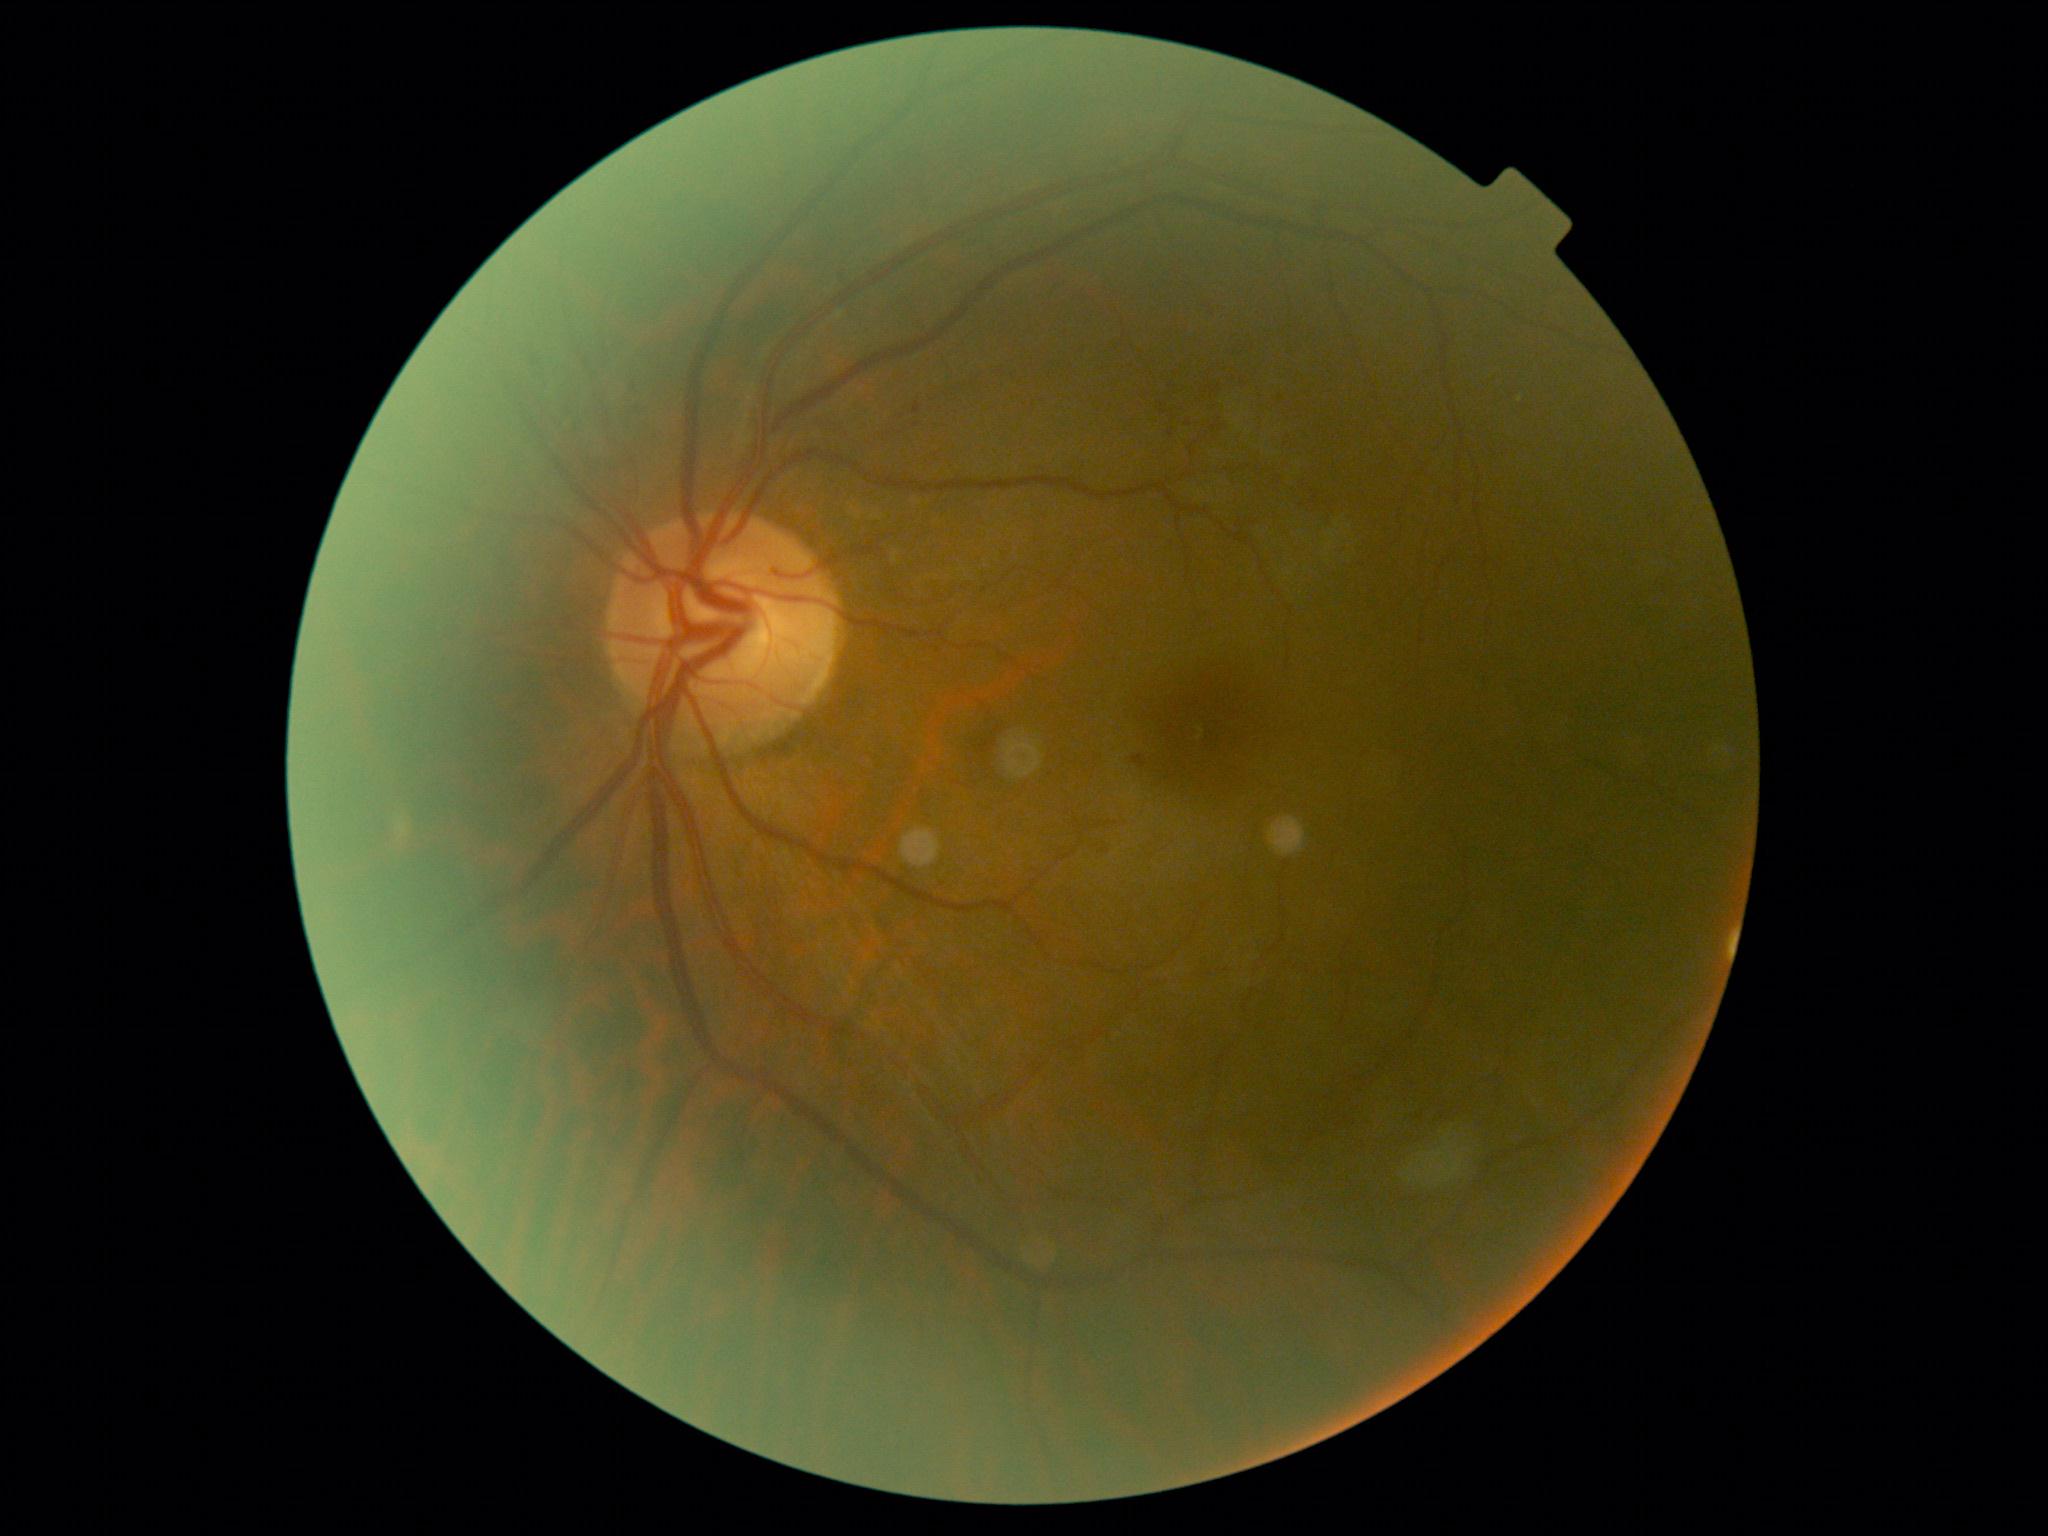 DR stage@grade 2 (moderate NPDR) — more than just microaneurysms but less than severe NPDR.